2048x1536: 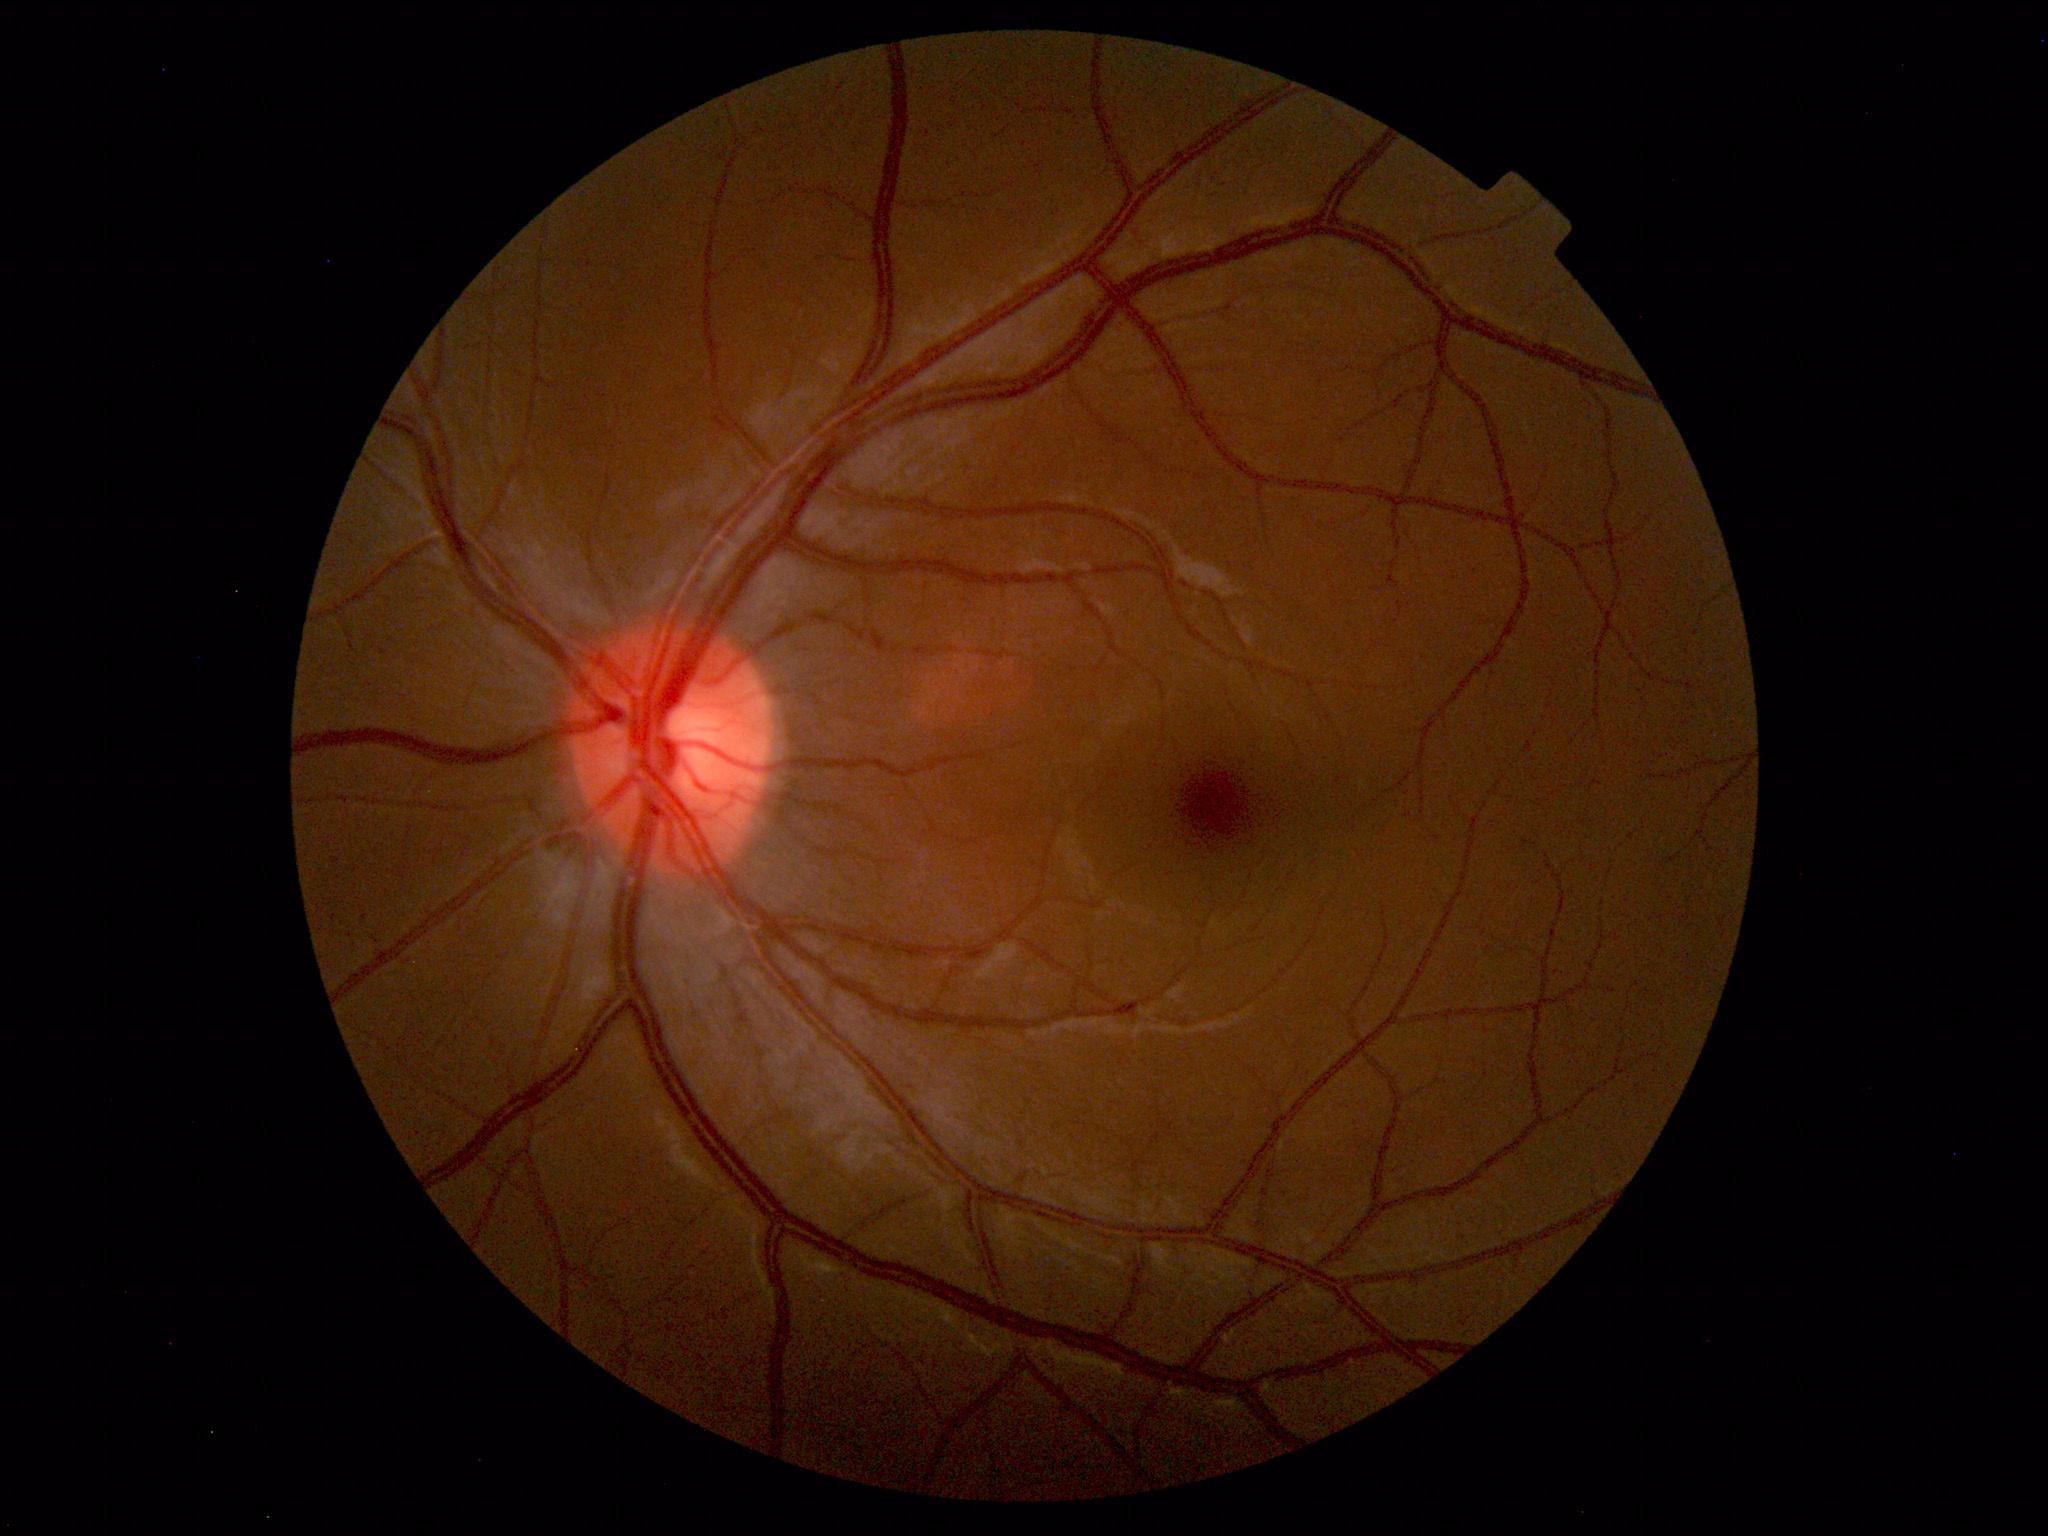

Impression: within normal limits.